Graded on the modified Davis scale · NIDEK AFC-230 fundus camera · no pharmacologic dilation · 848 by 848 pixels · 45 degree fundus photograph
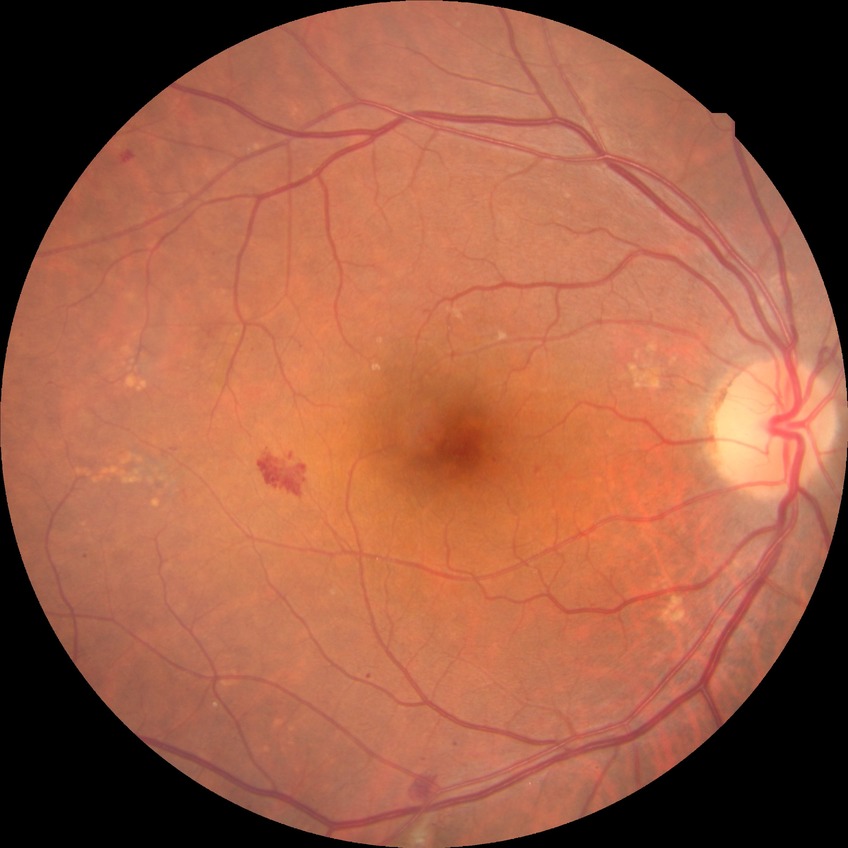
Diabetic retinopathy (DR) is simple diabetic retinopathy (SDR).